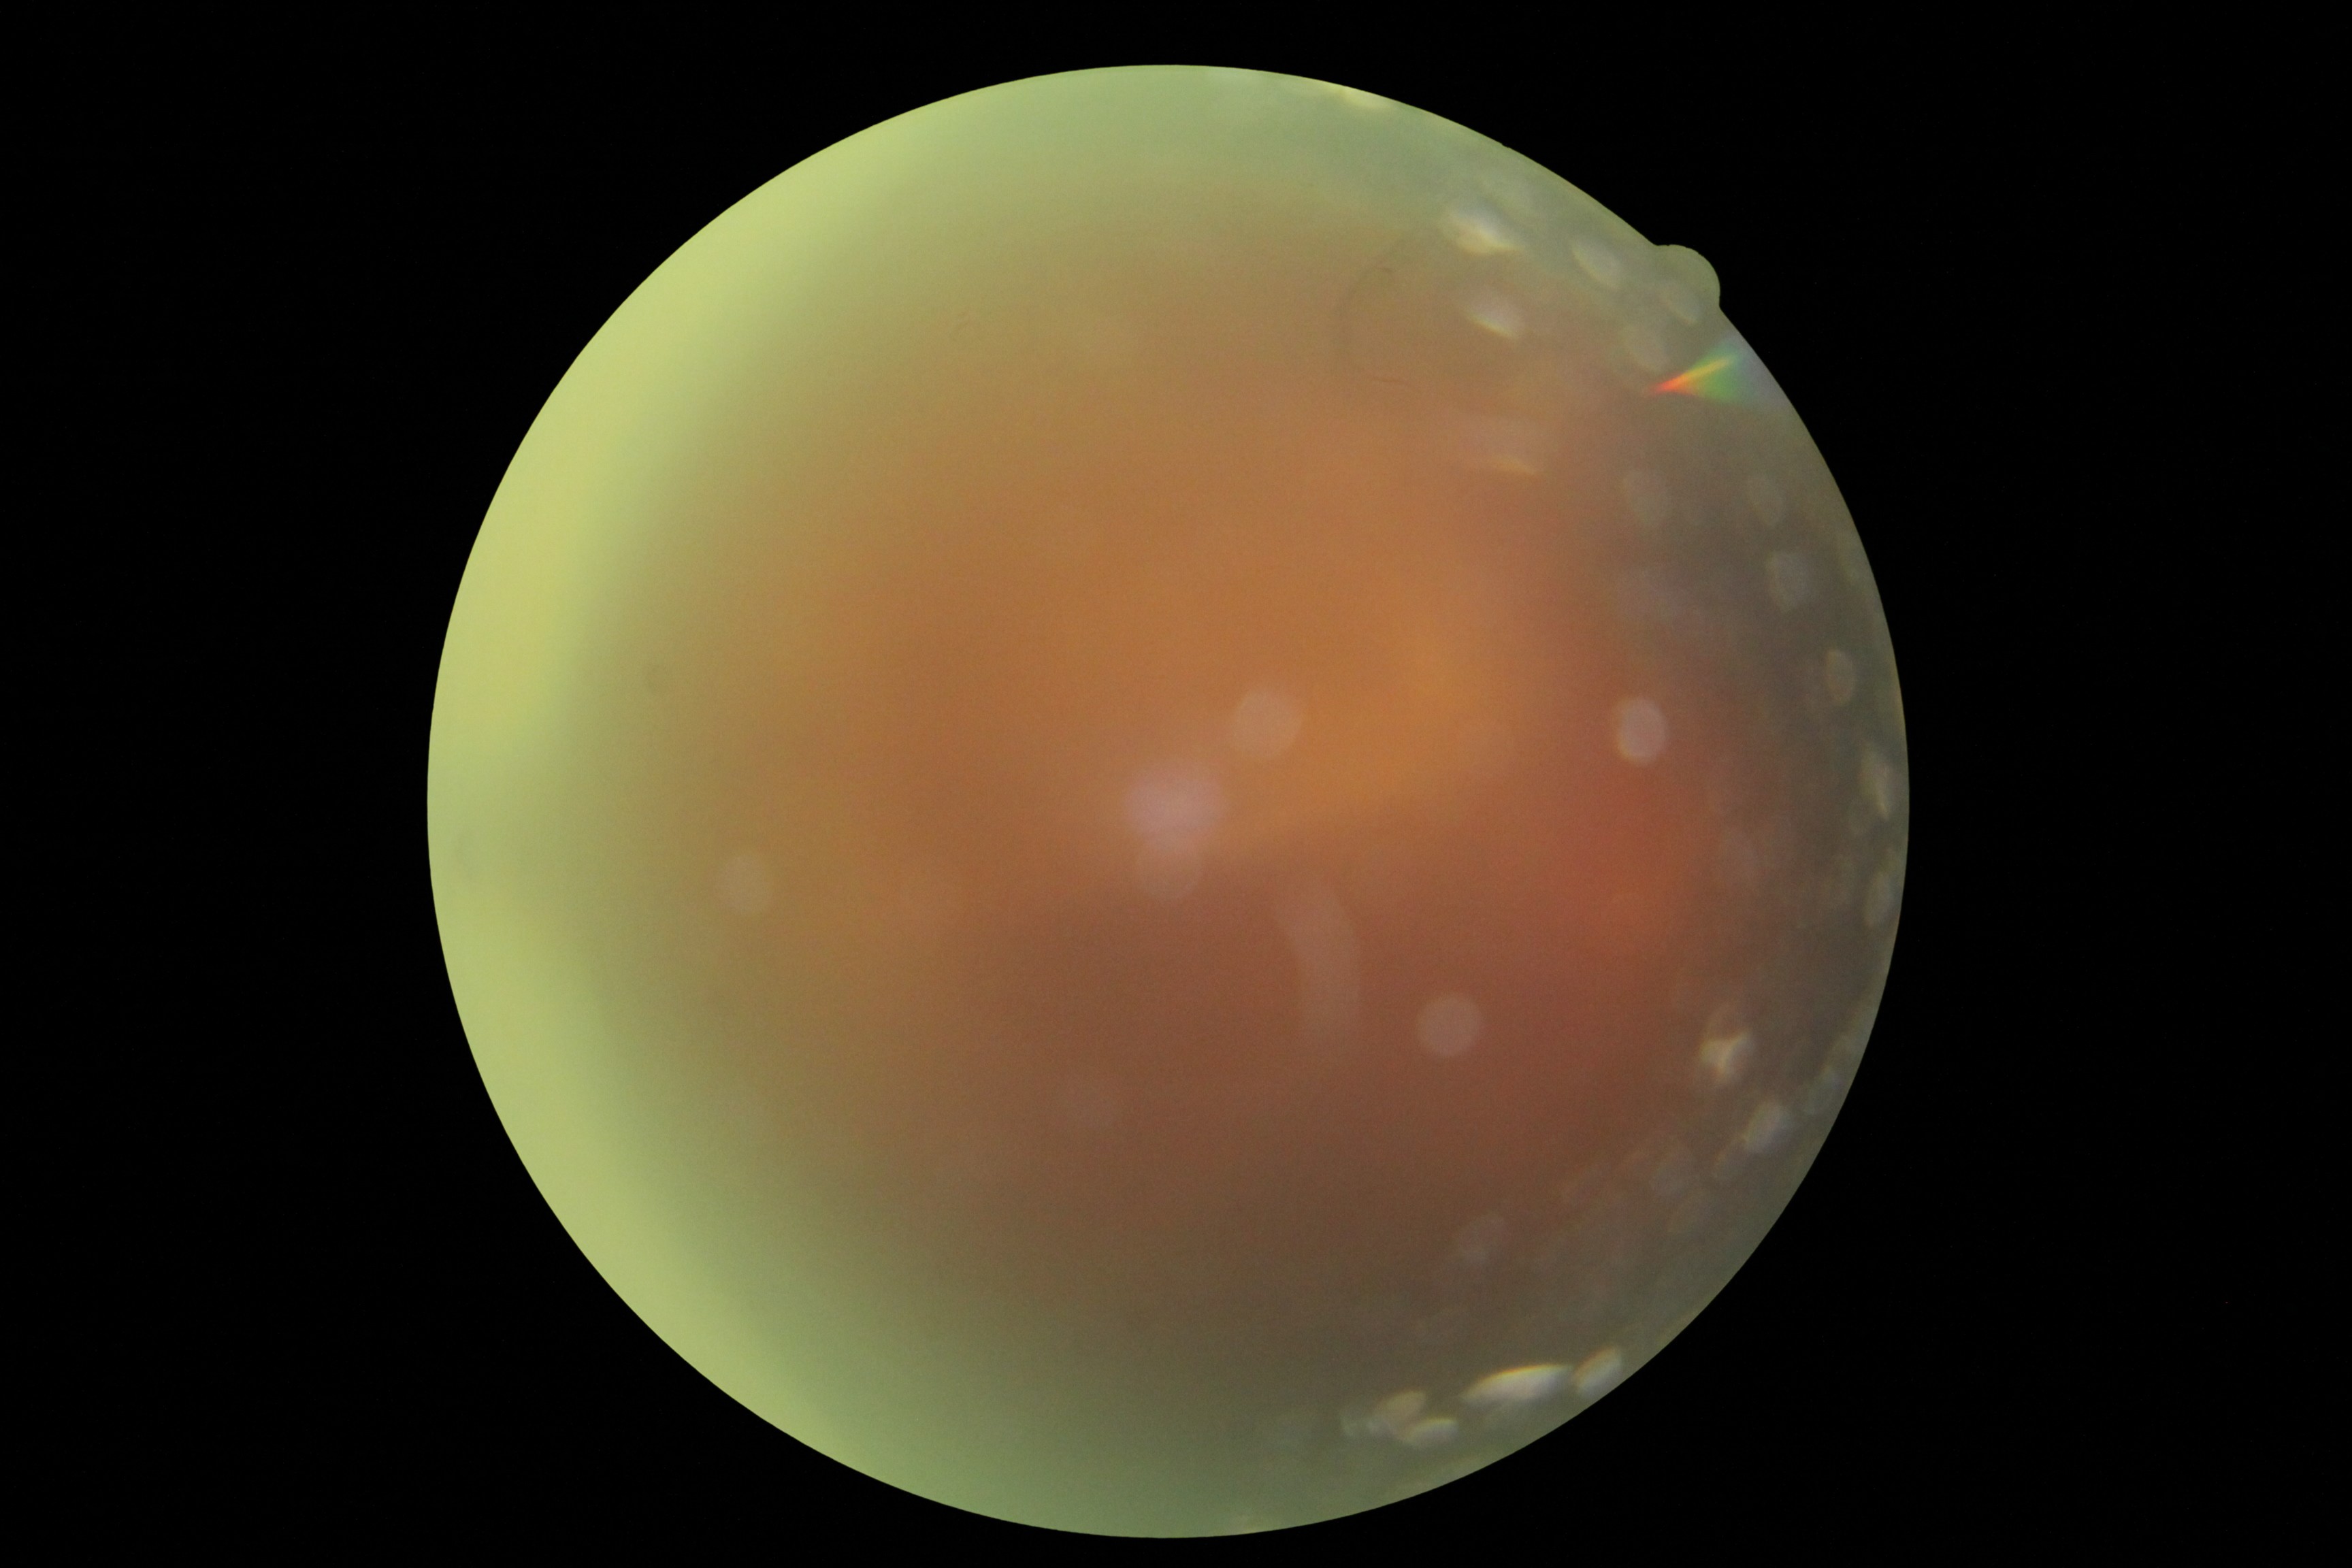

Retinopathy: ungradable.
The image cannot be graded for diabetic retinopathy.